45° FOV. Fundus photo. NIDEK AFC-230. Nonmydriatic fundus photograph — 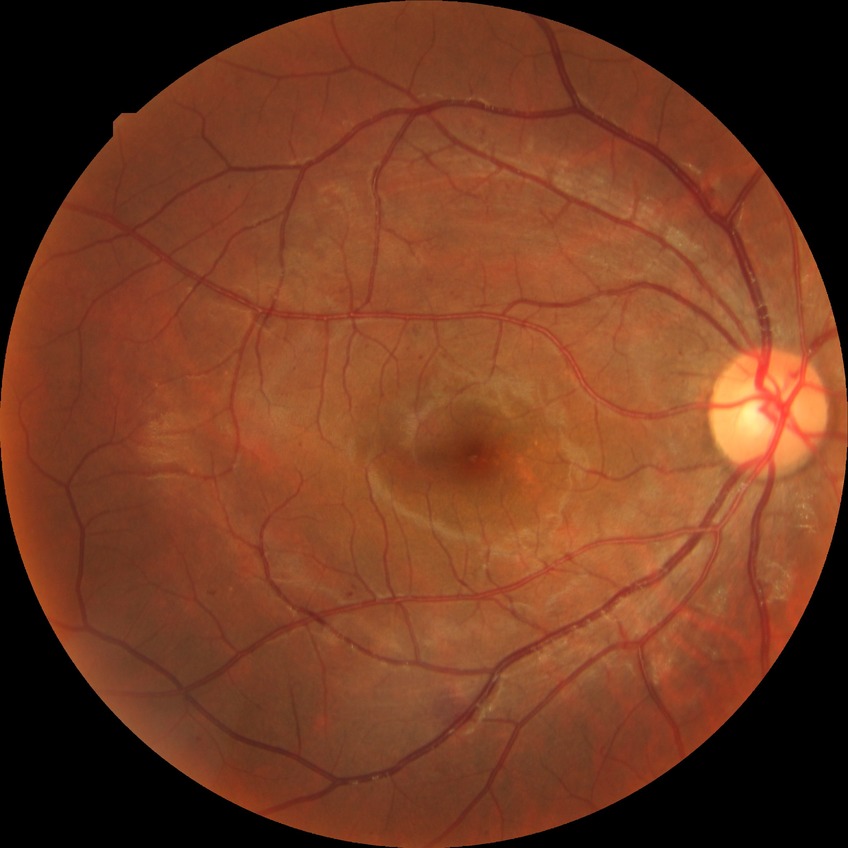

Davis grading is simple diabetic retinopathy. DR class: non-proliferative diabetic retinopathy.